Image size 2228x1652 · camera: Topcon TRC-50DX · fundus photo · posterior pole field covering the optic disc and macula:
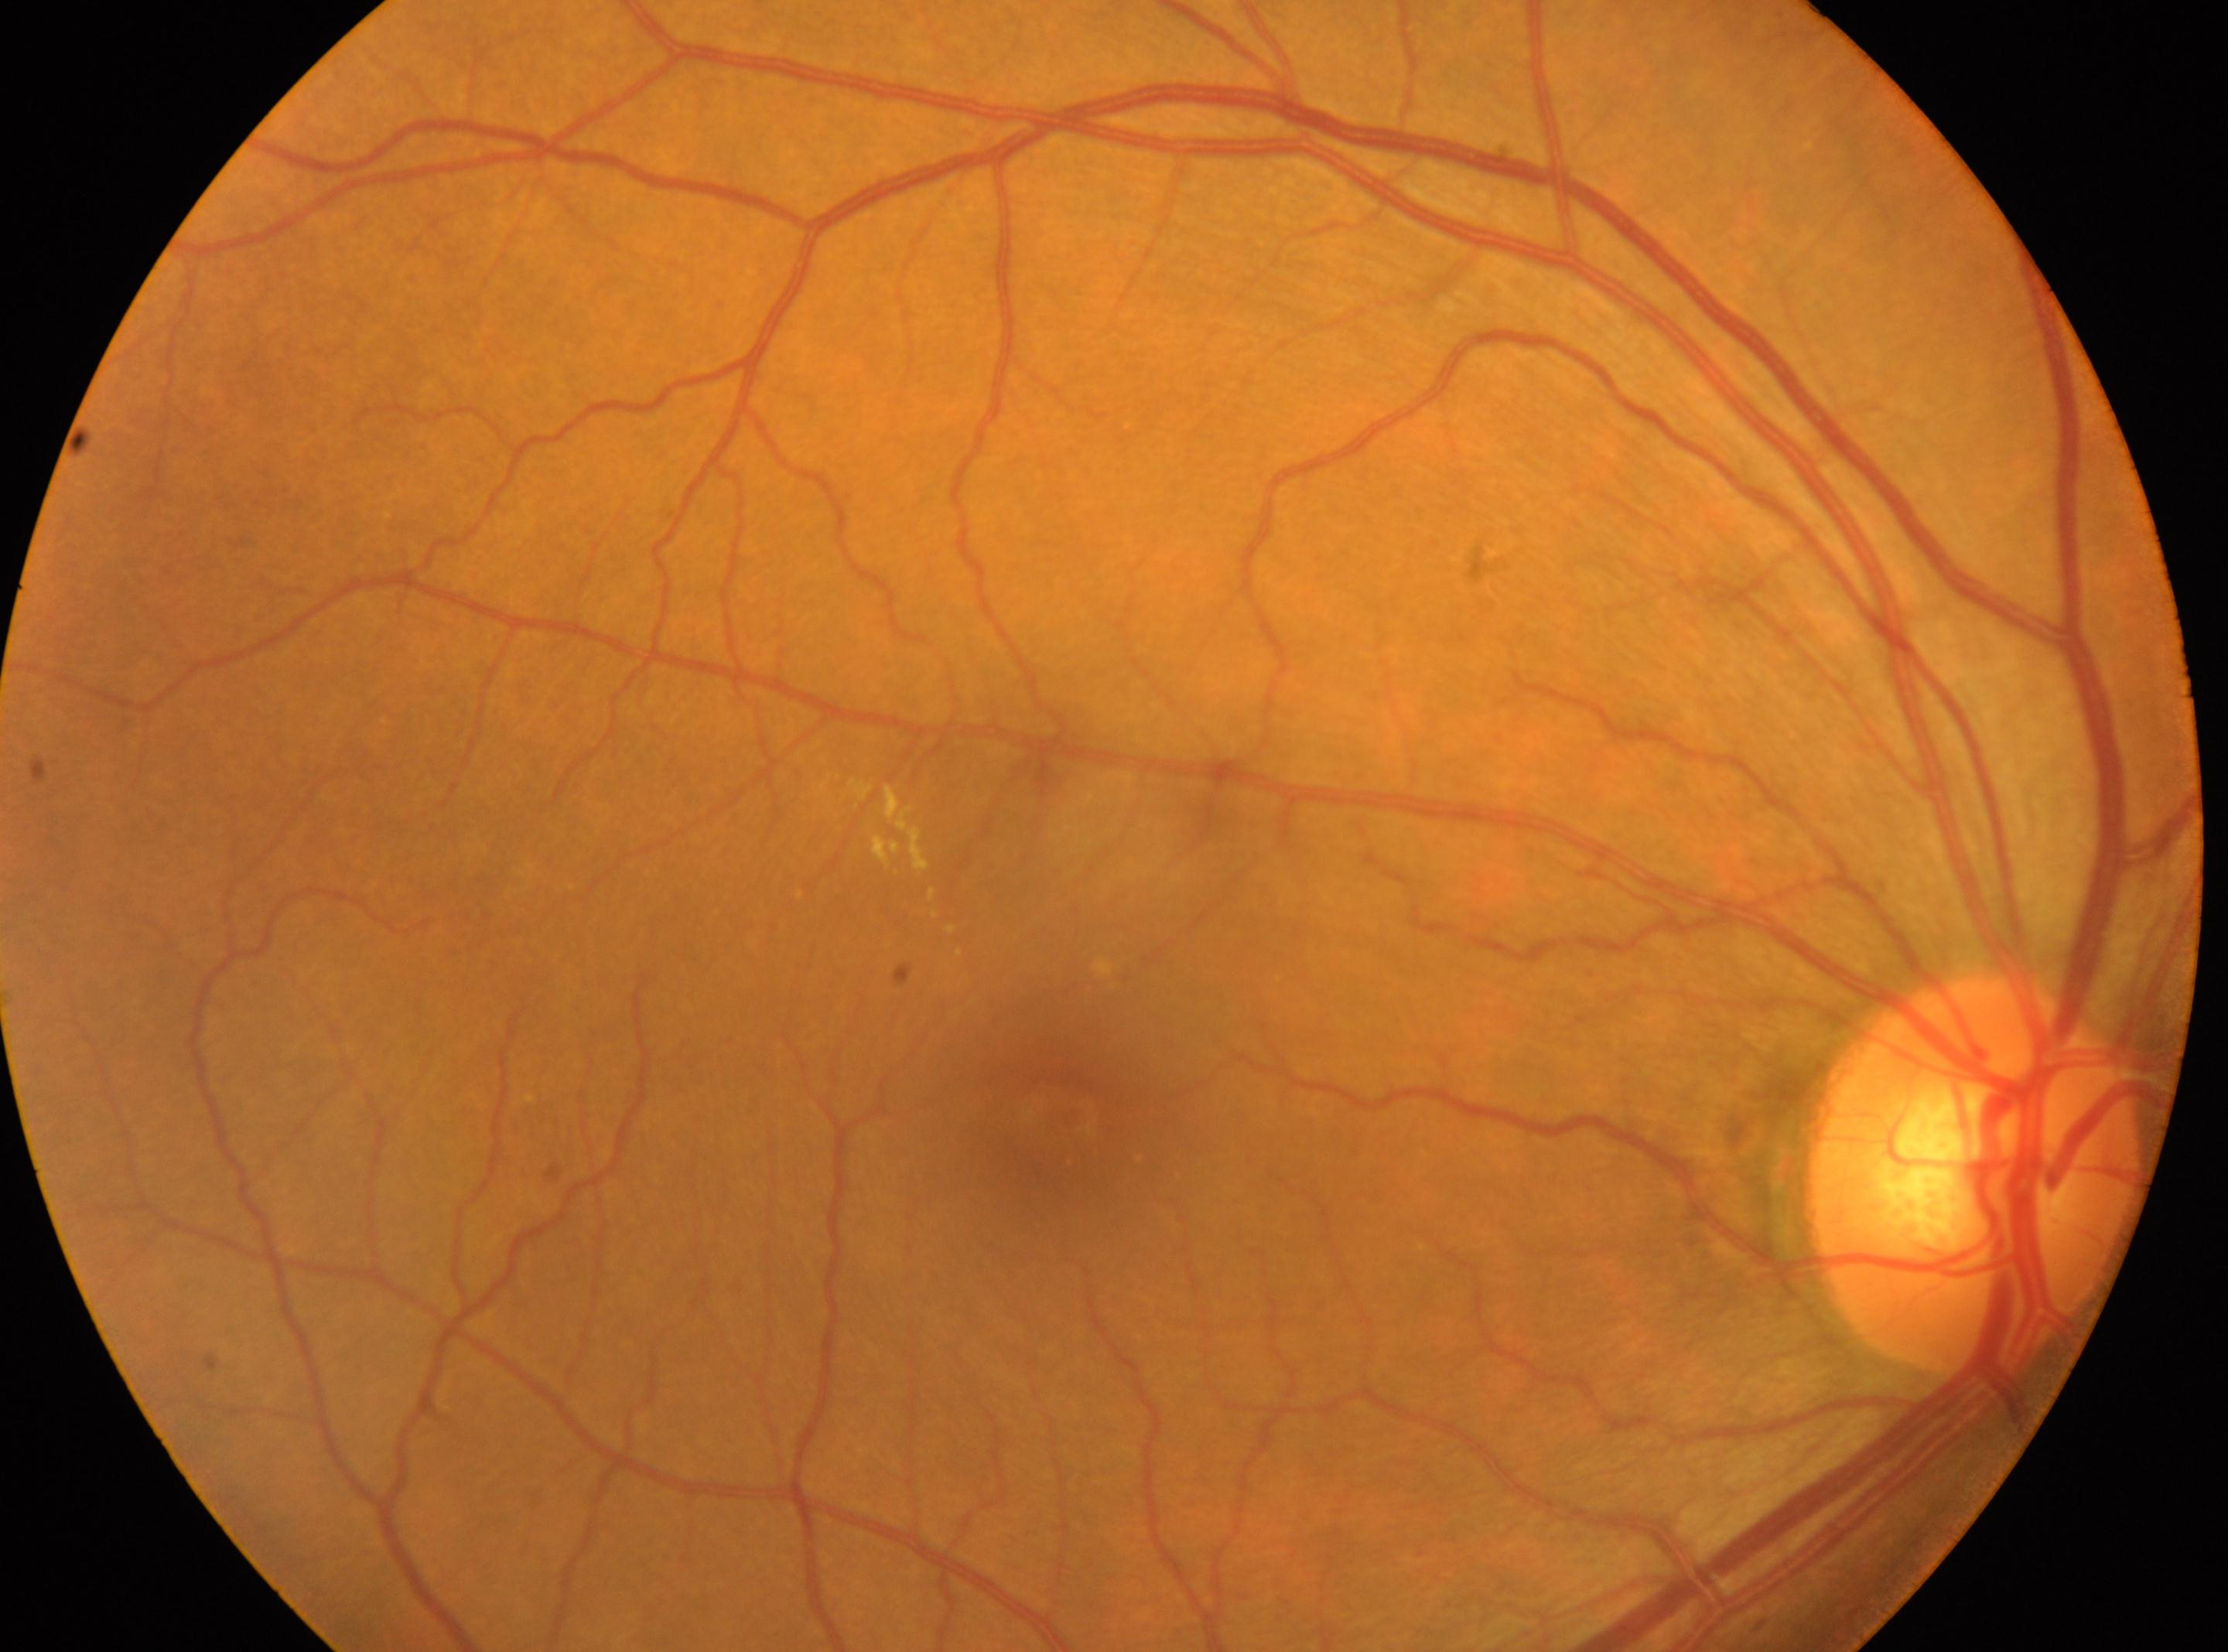   optic_disc: [1974, 1176]
  dr_grade: 2 (moderate NPDR)
  eye: OD
  fovea: [1068, 1118]